Acquired on the Phoenix ICON · Phoenix ICON wide-field infant fundus image · 1240x1240
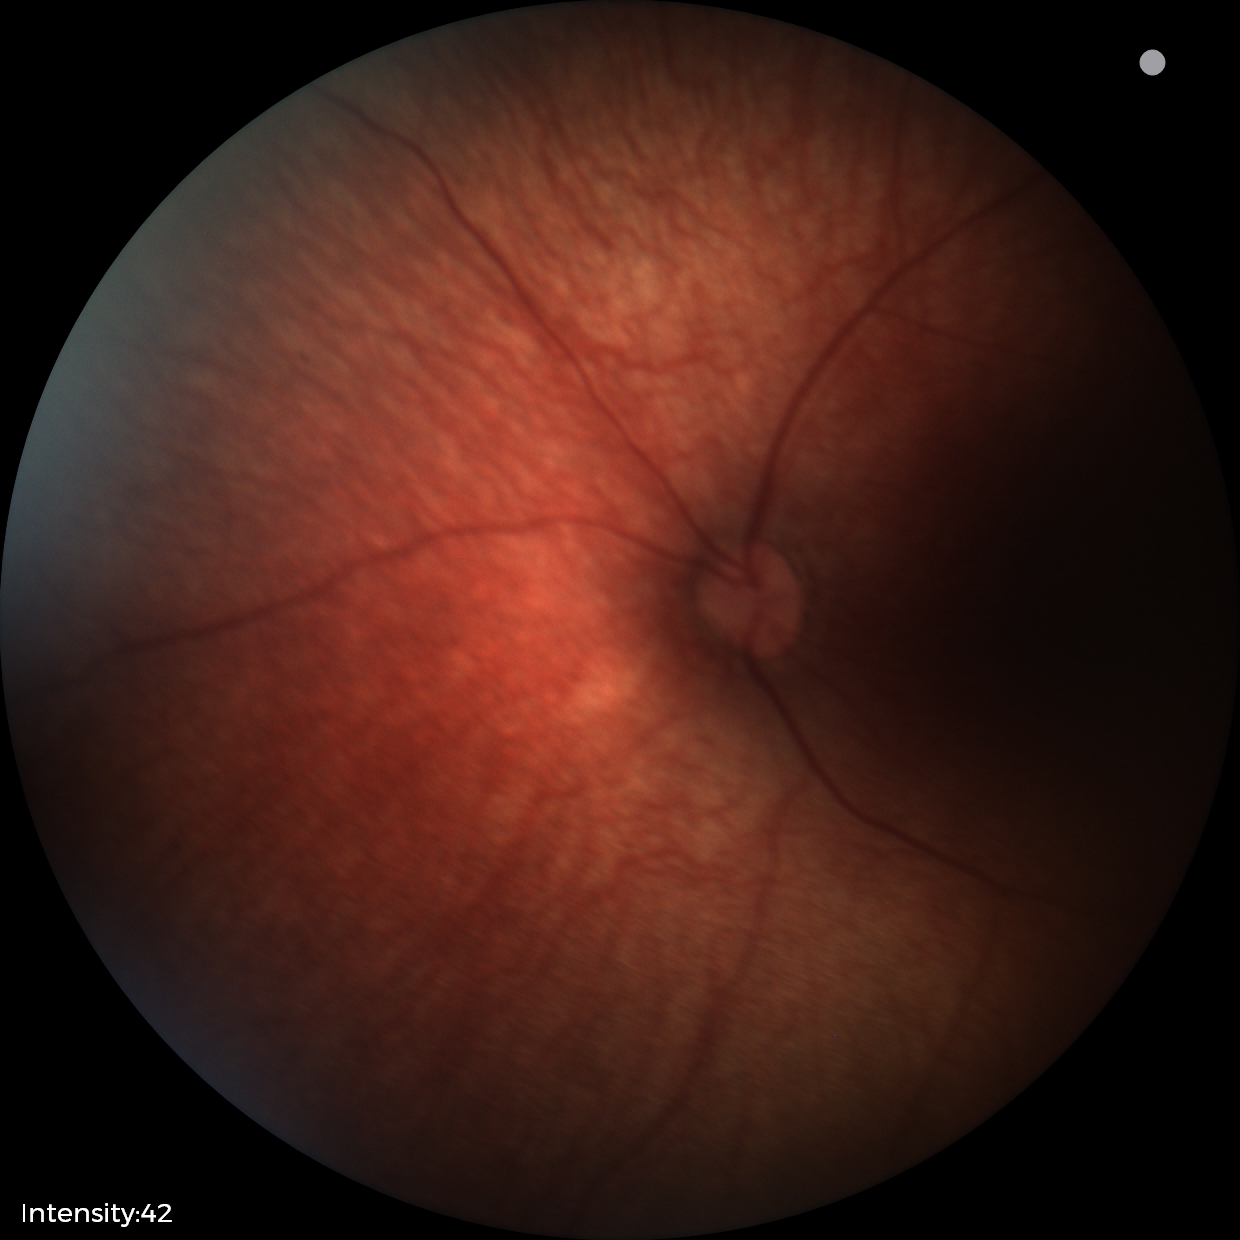
Screening examination diagnosed as physiological.